Color fundus image, 45° field of view.
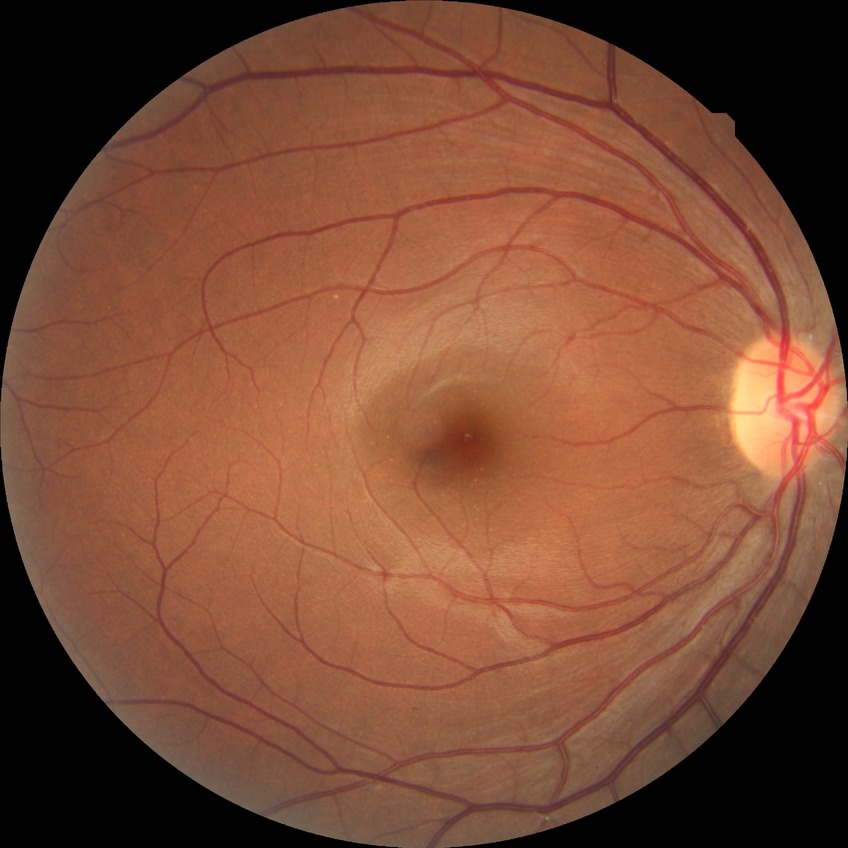 Diabetic retinopathy (DR) is no diabetic retinopathy (NDR).